Retinal fundus photograph, 45° FOV.
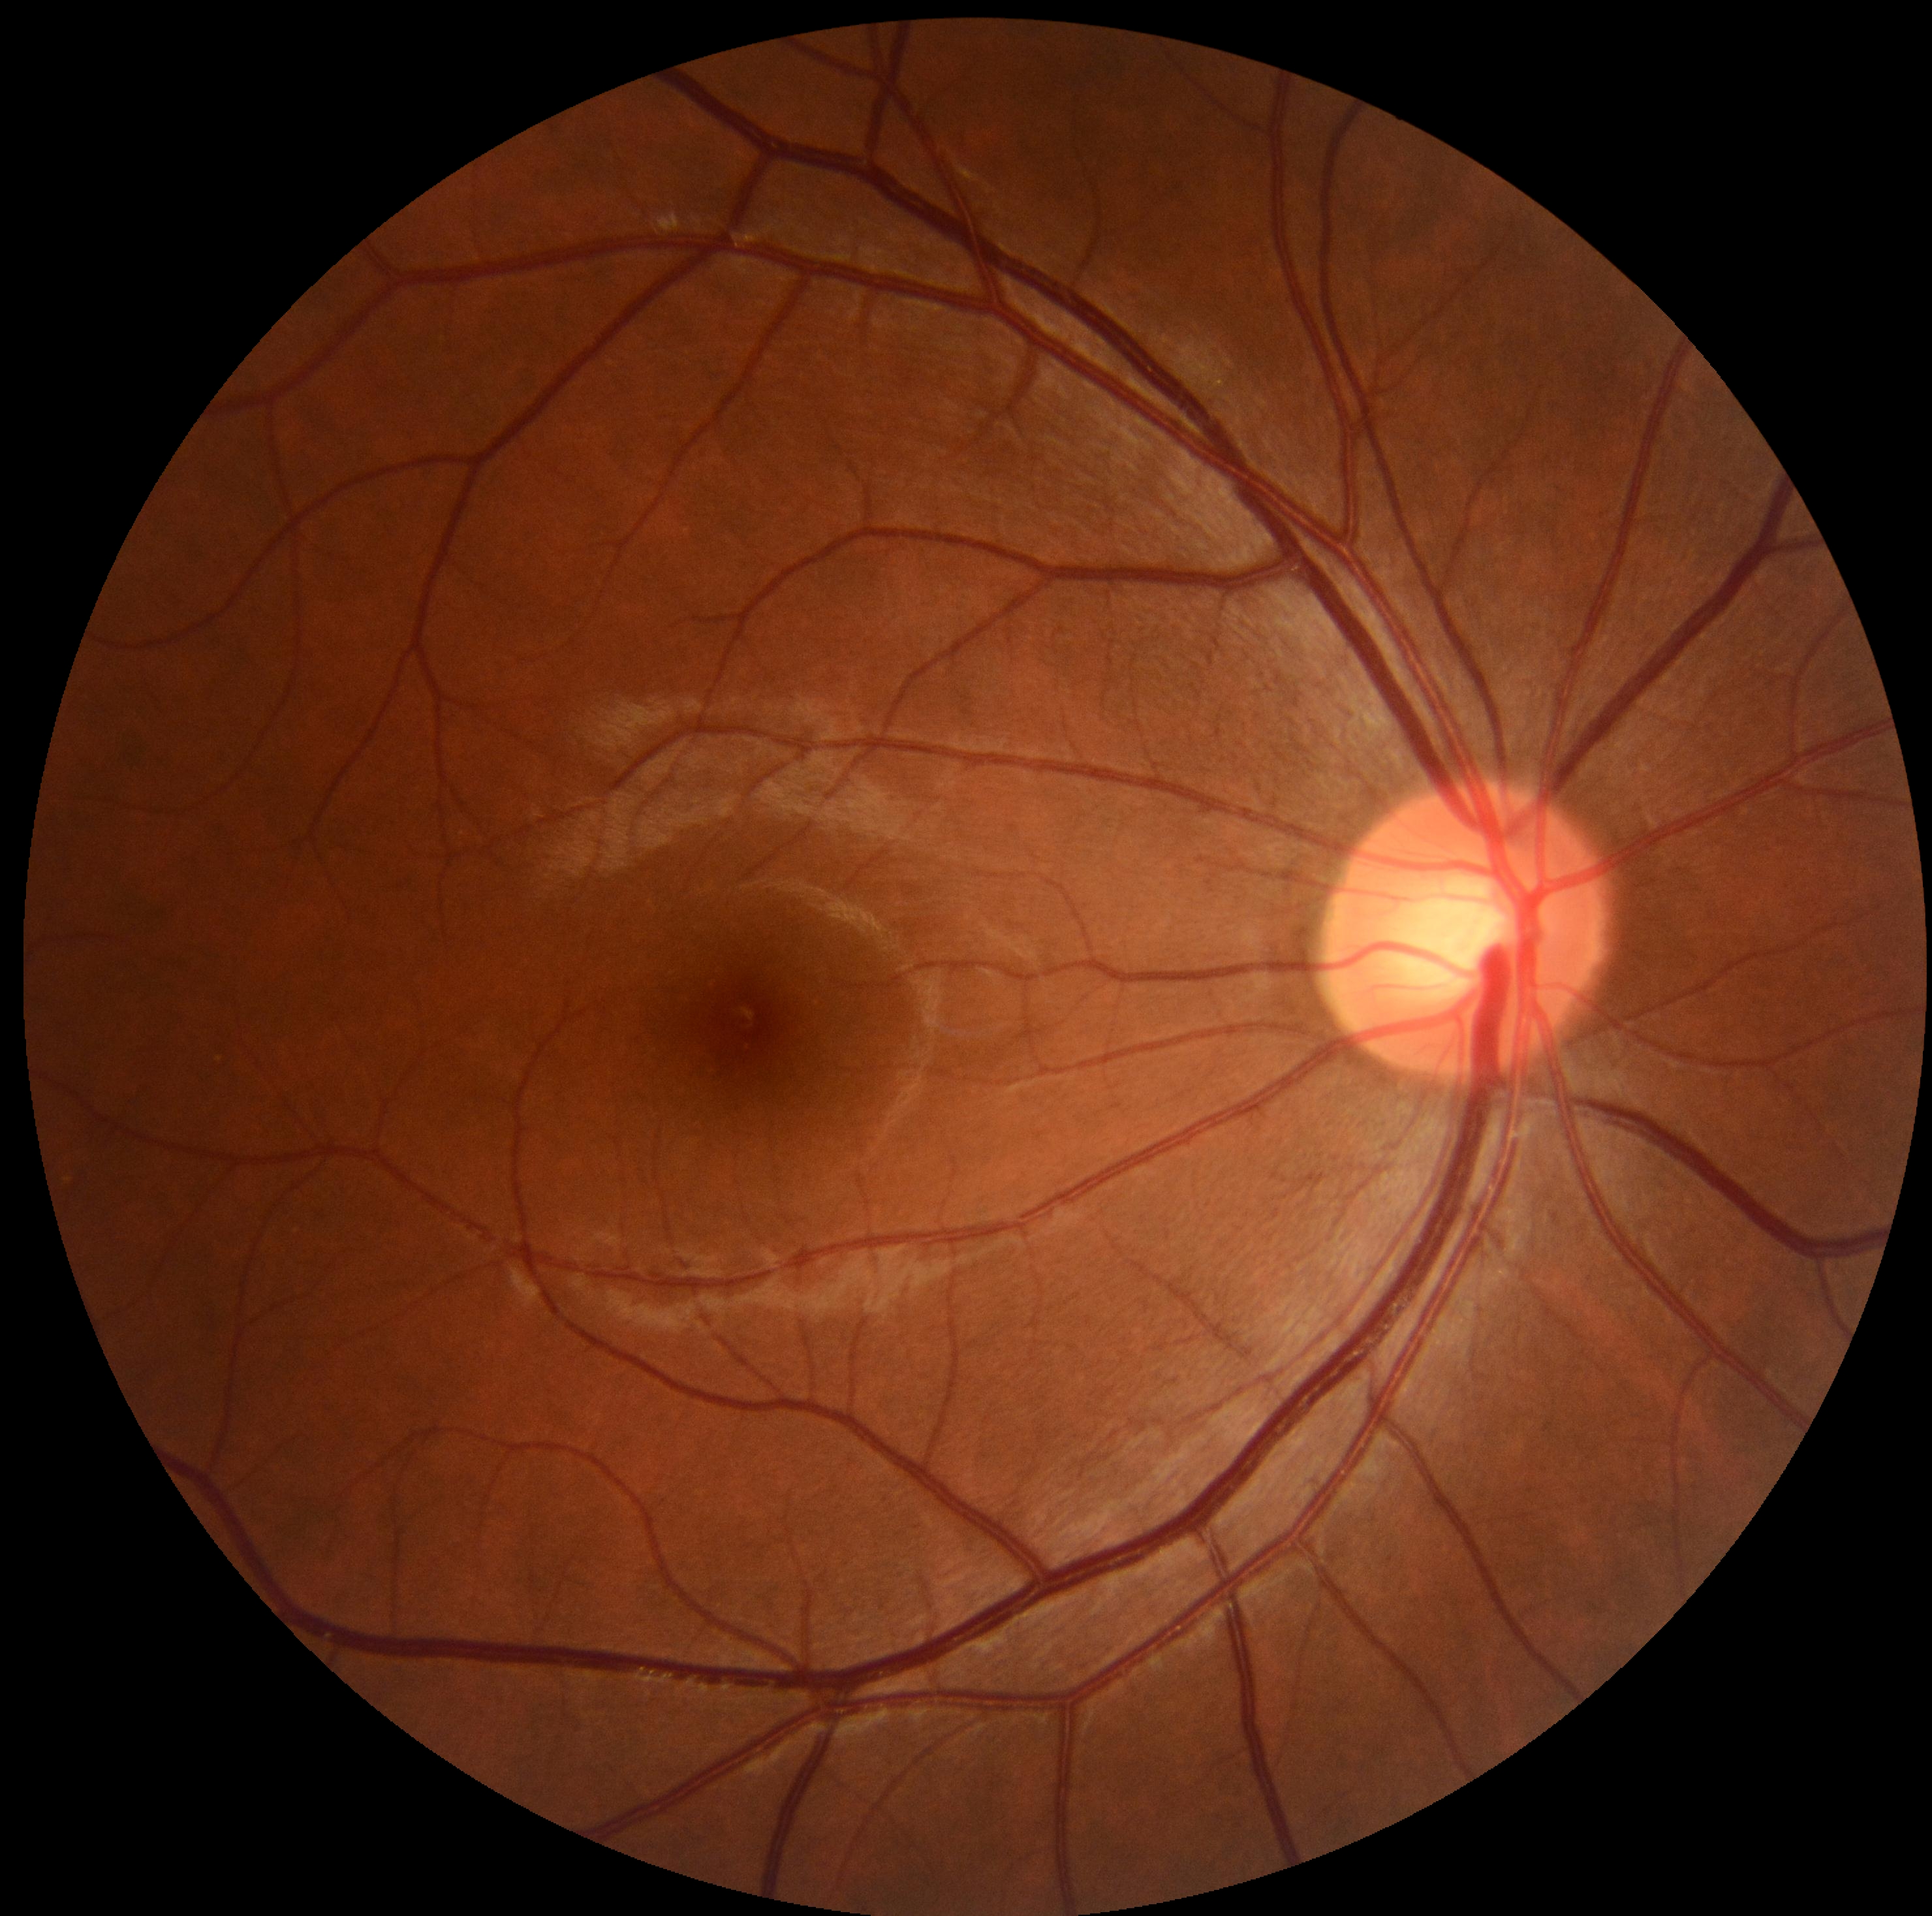 retinopathy grade: 0.